Color fundus photograph. FOV: 45 degrees.
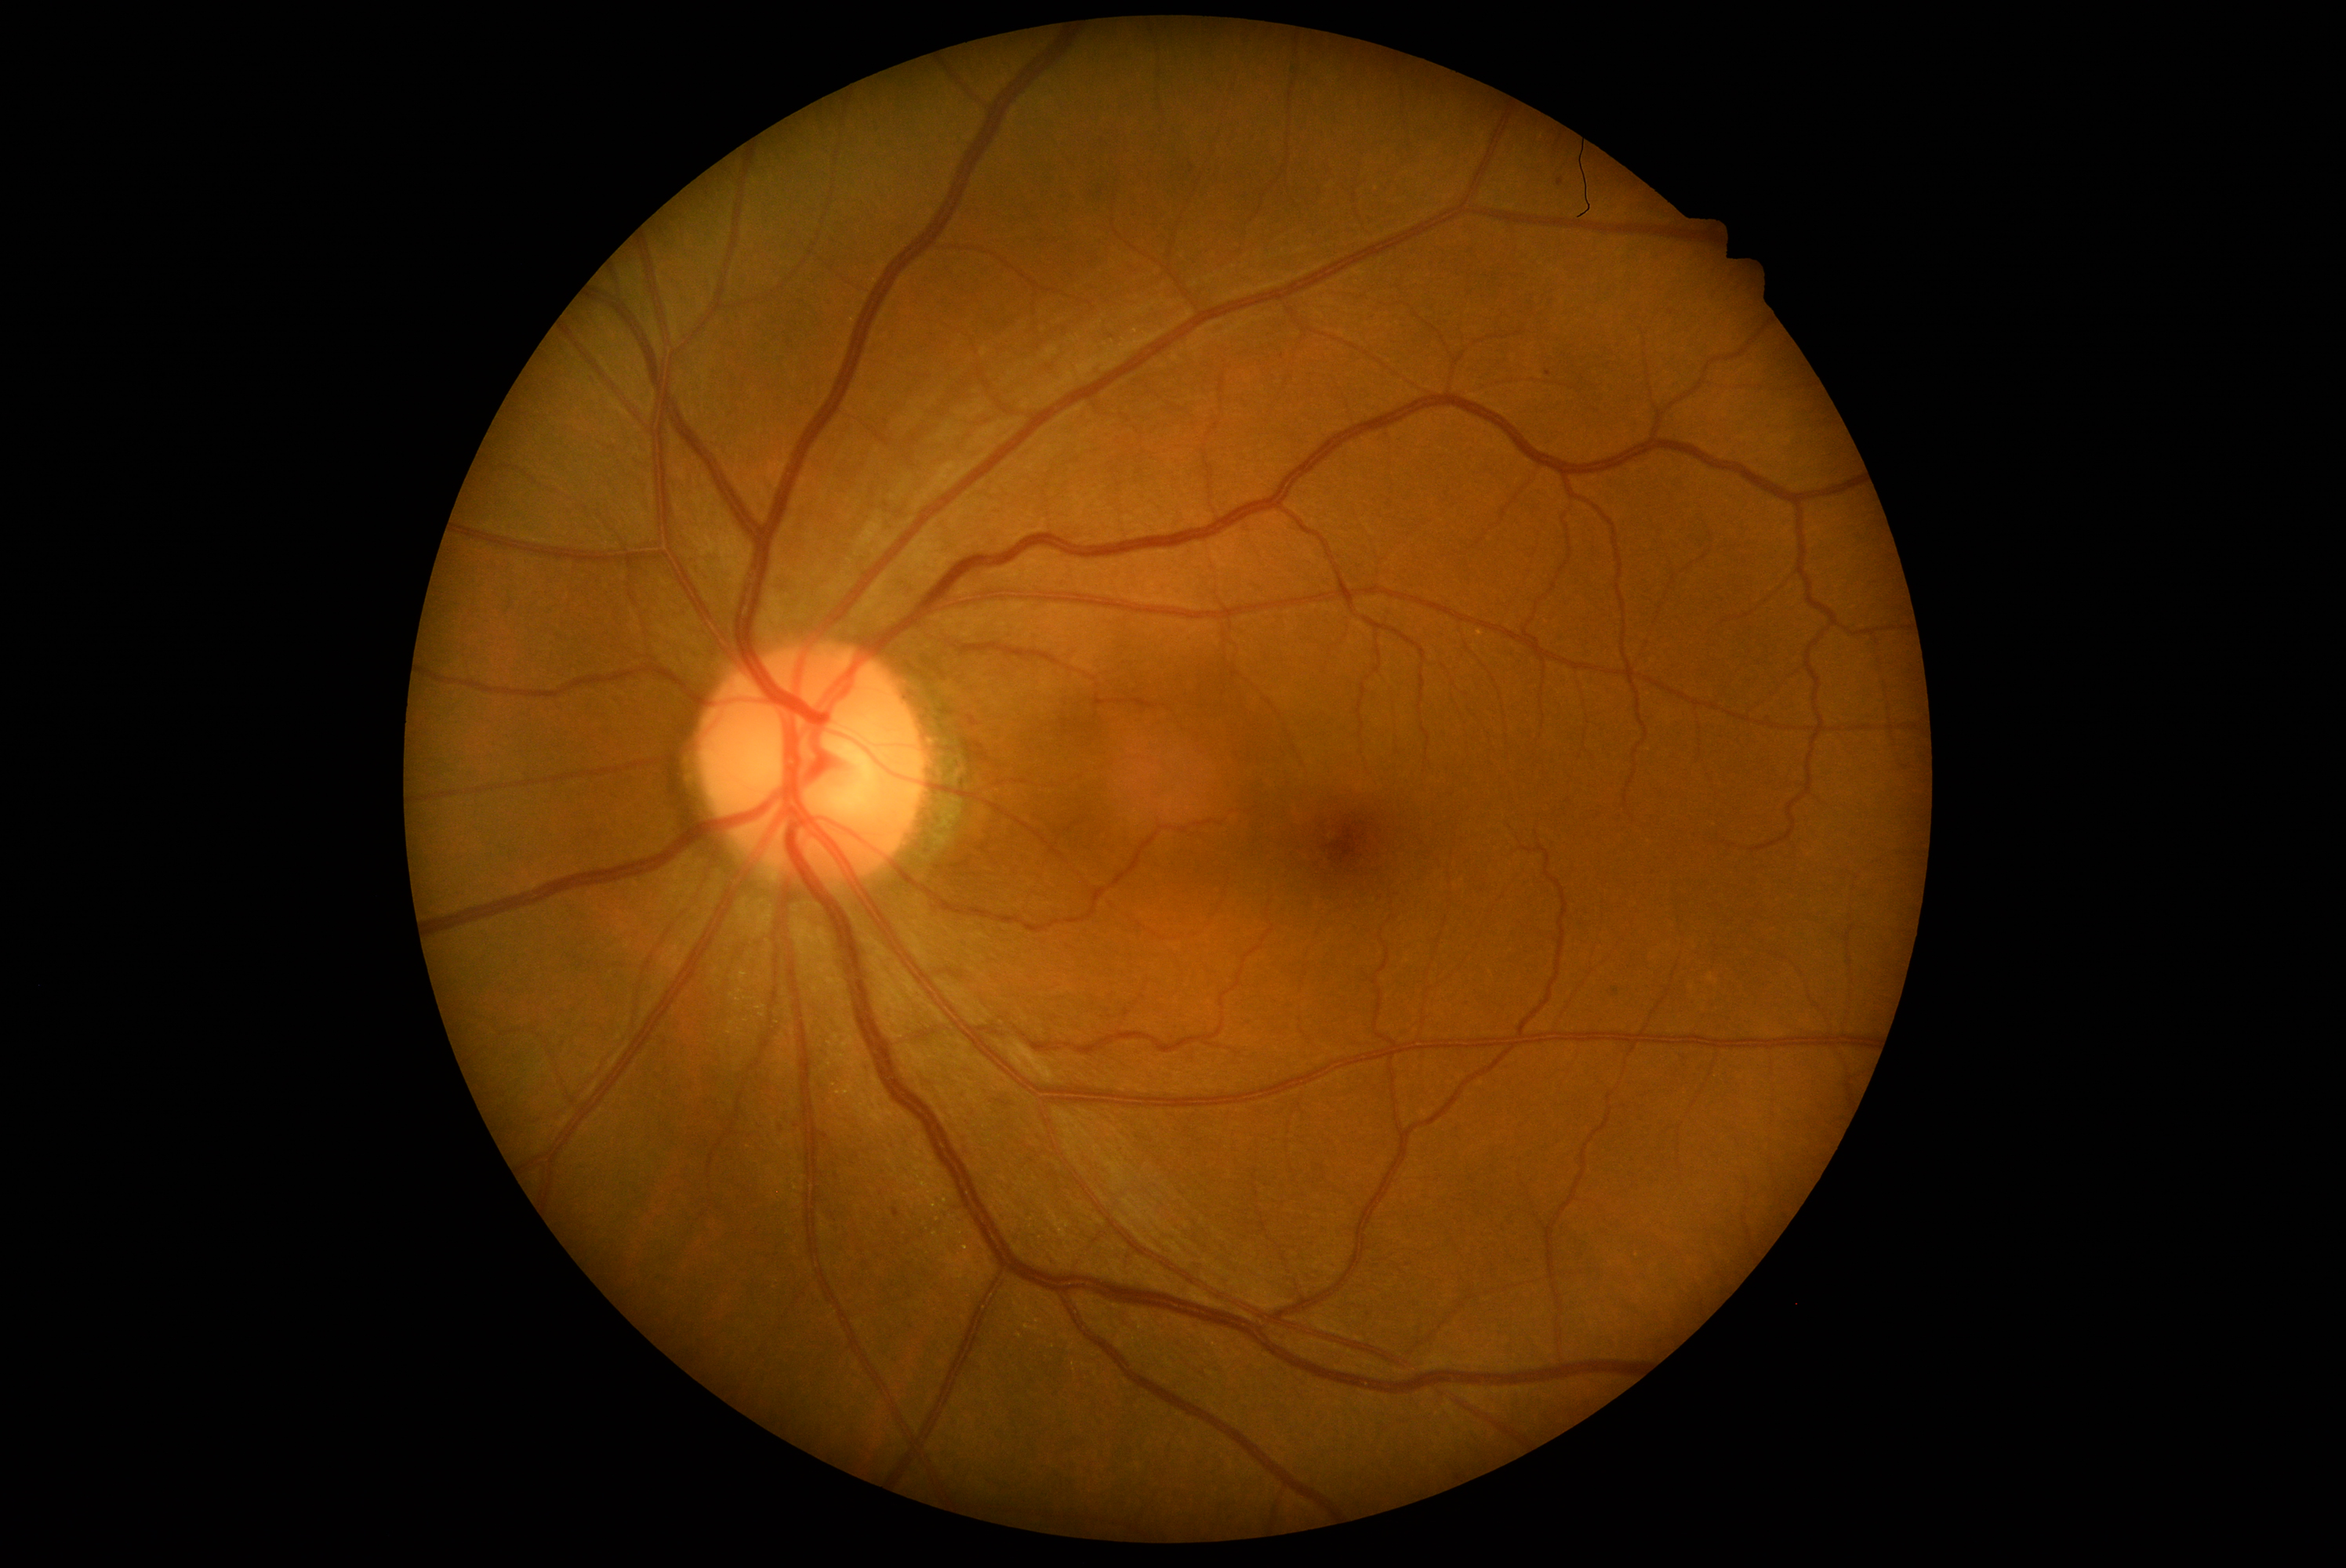

DR stage: grade 1.